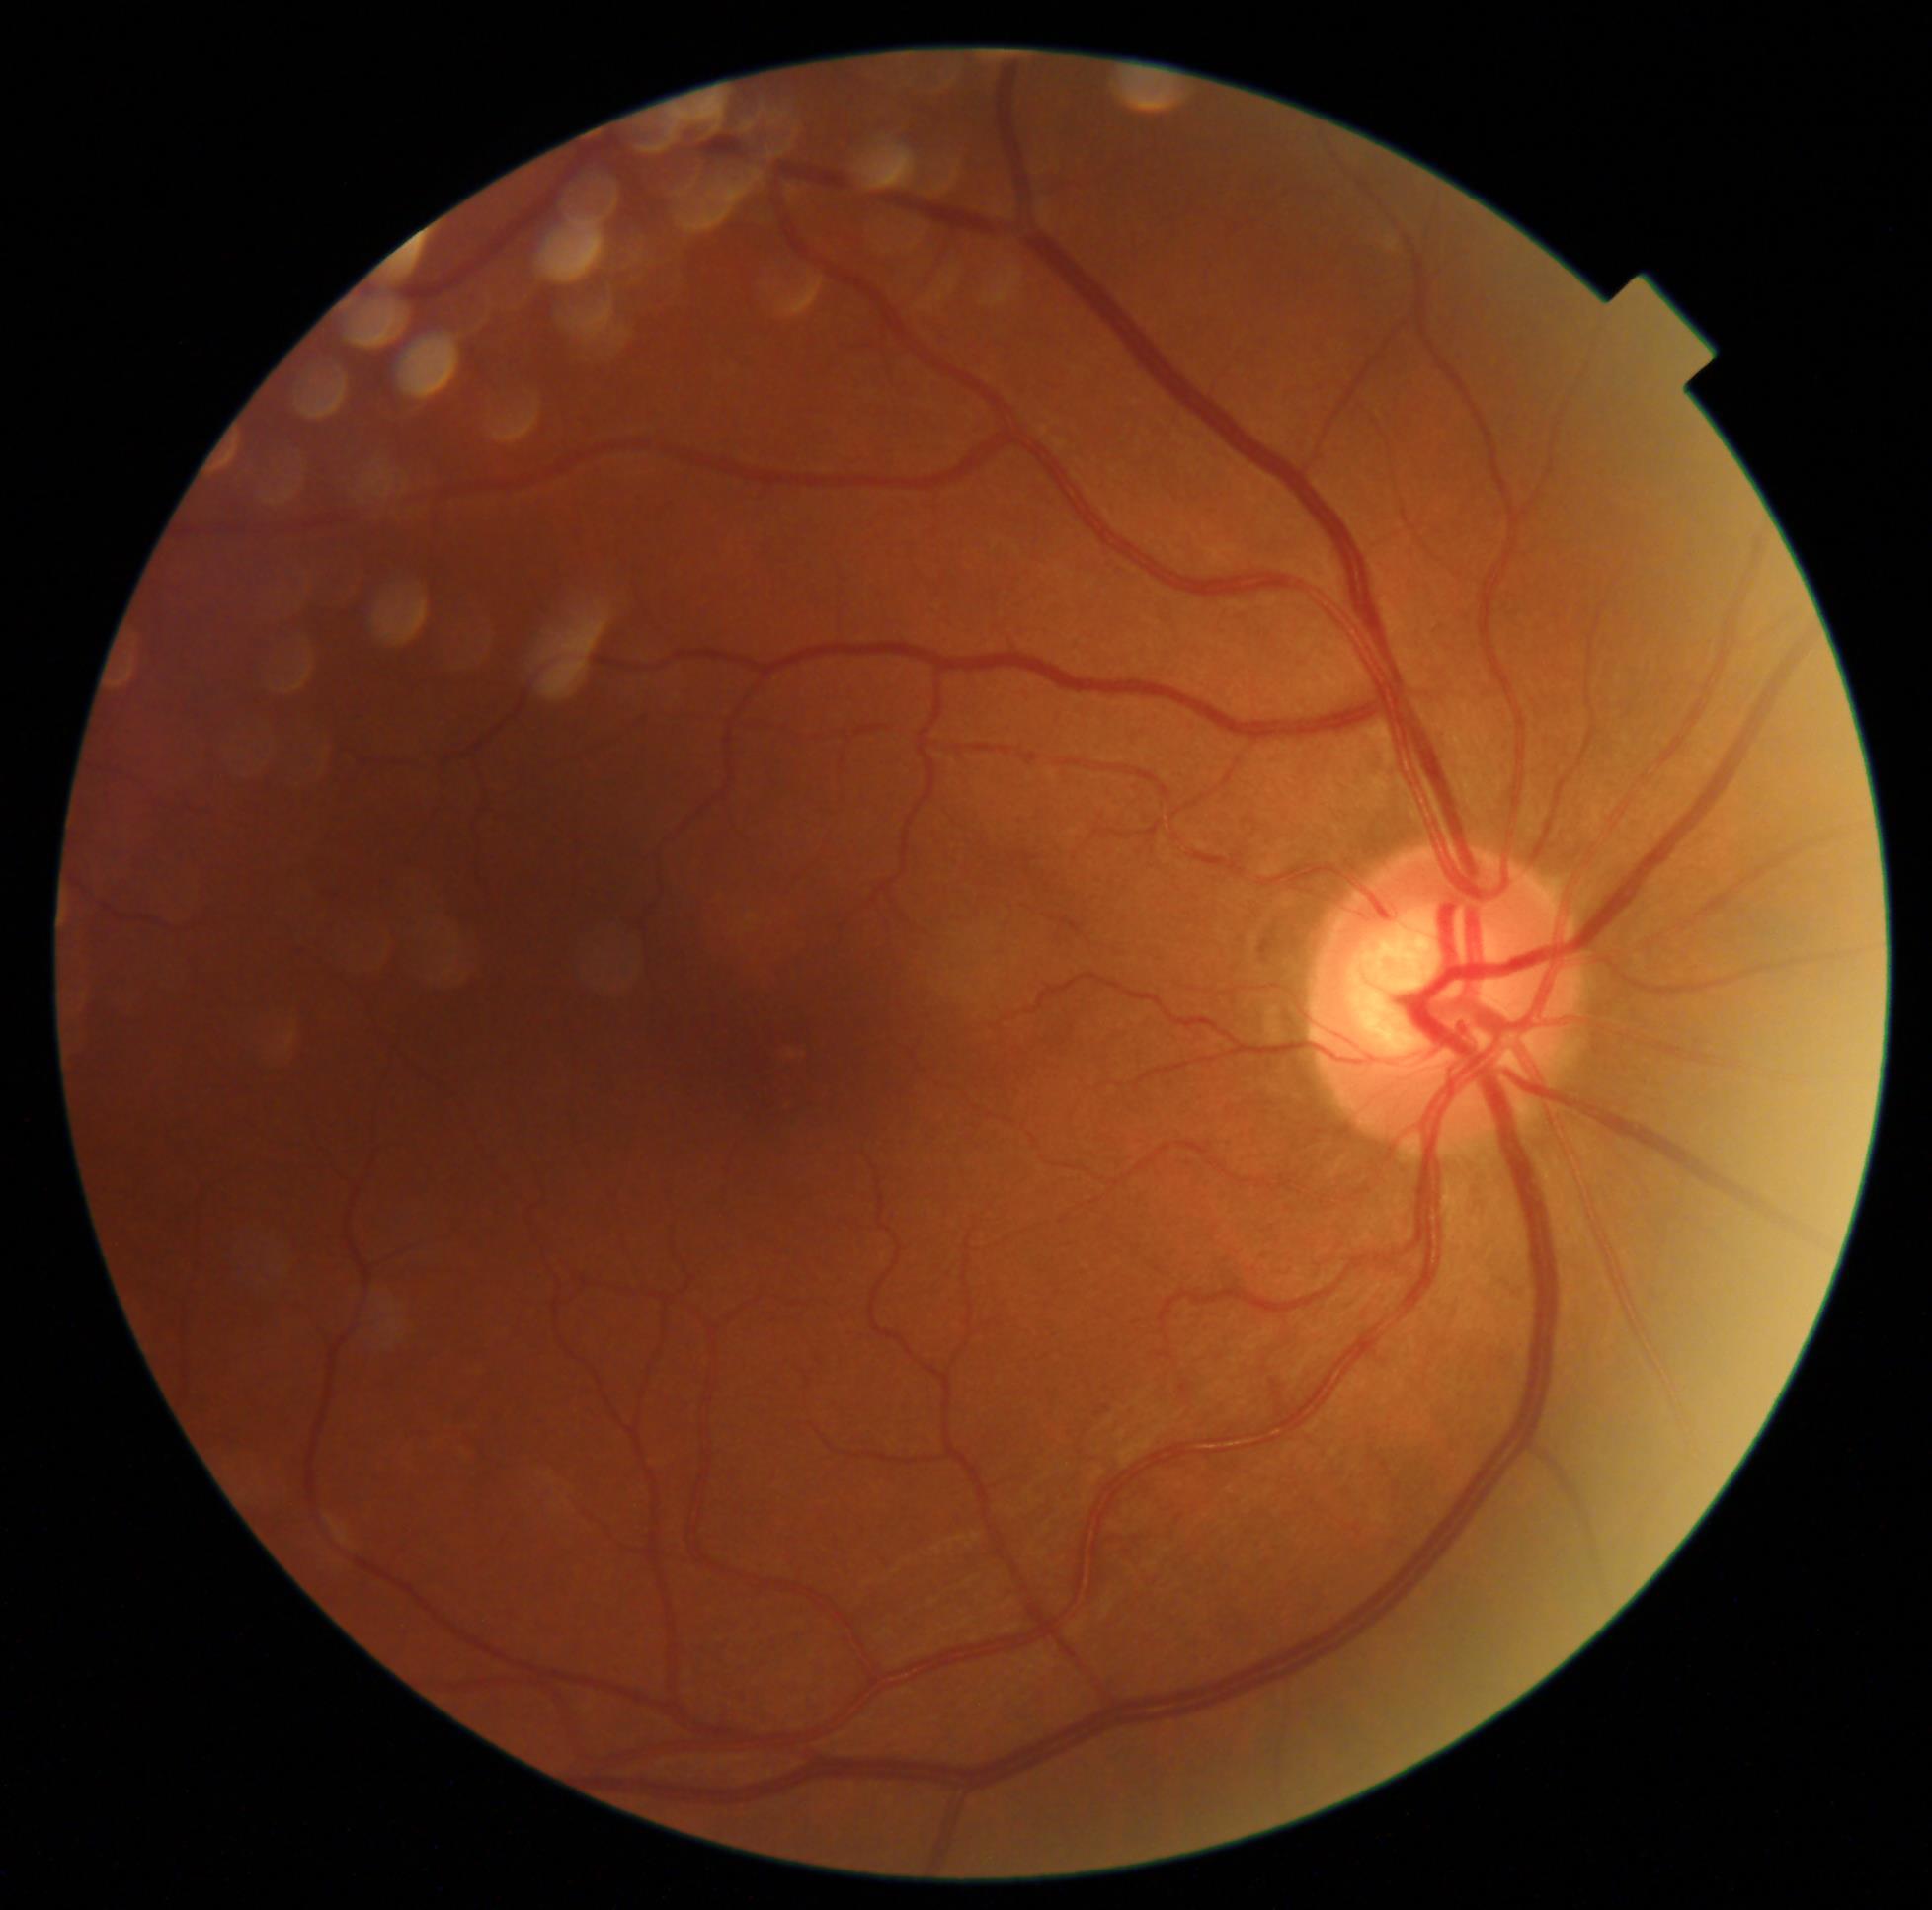 DR severity = 0/4 — no visible signs of diabetic retinopathy.